FOV: 45 degrees · CFP · acquired with a NIDEK AFC-230 · nonmydriatic fundus photograph — 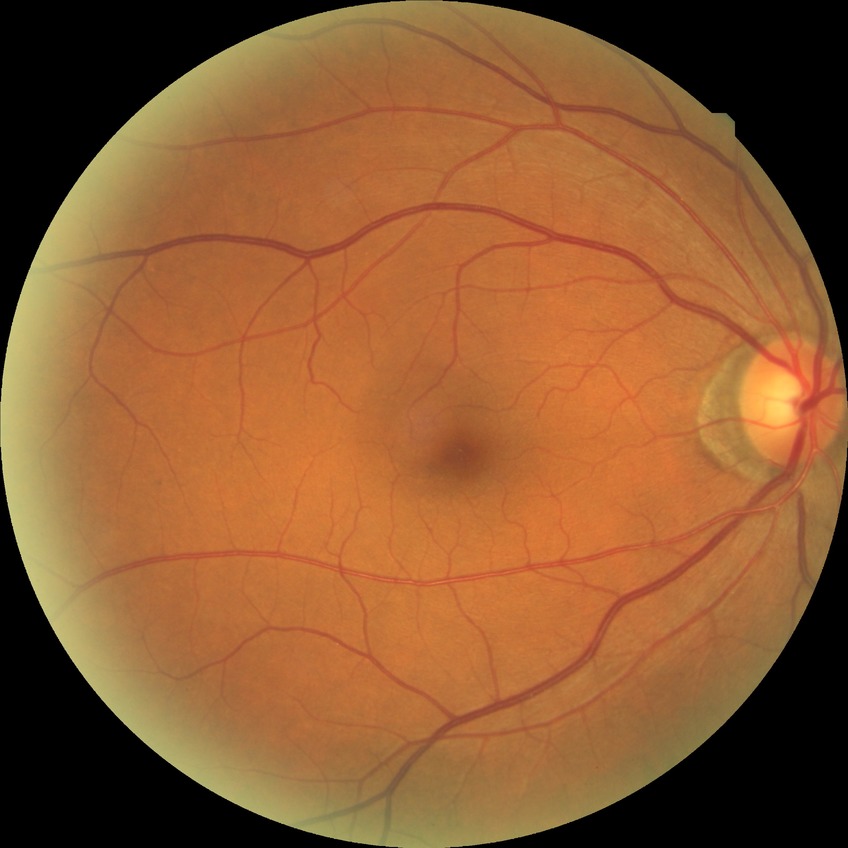
Diabetic retinopathy (DR): NDR (no diabetic retinopathy).